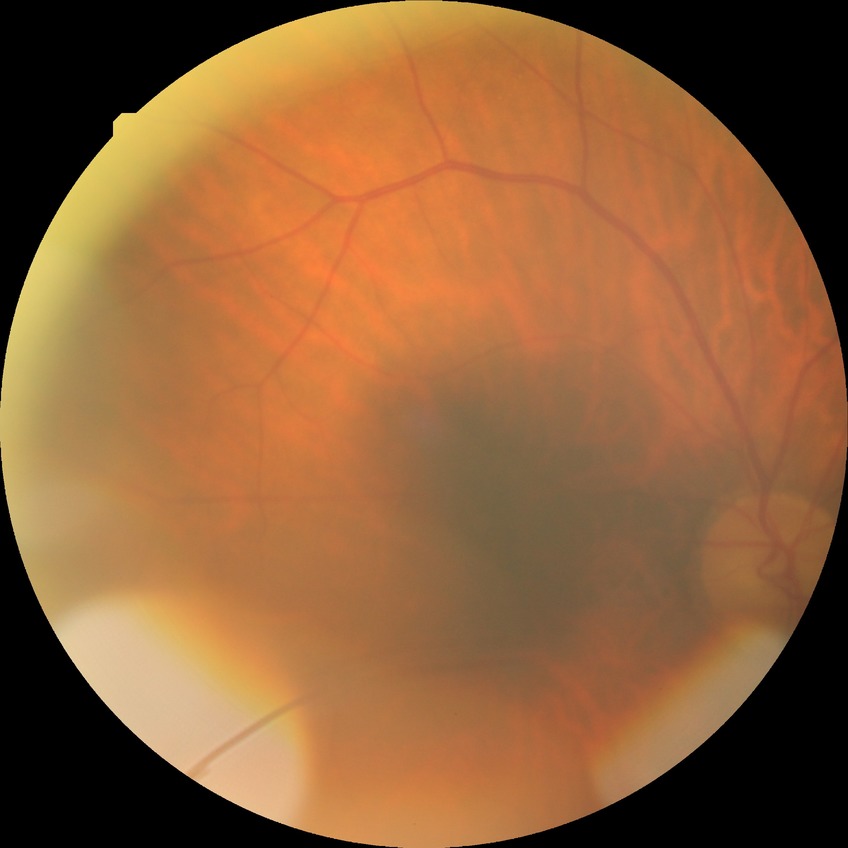

DR grade=NDR.